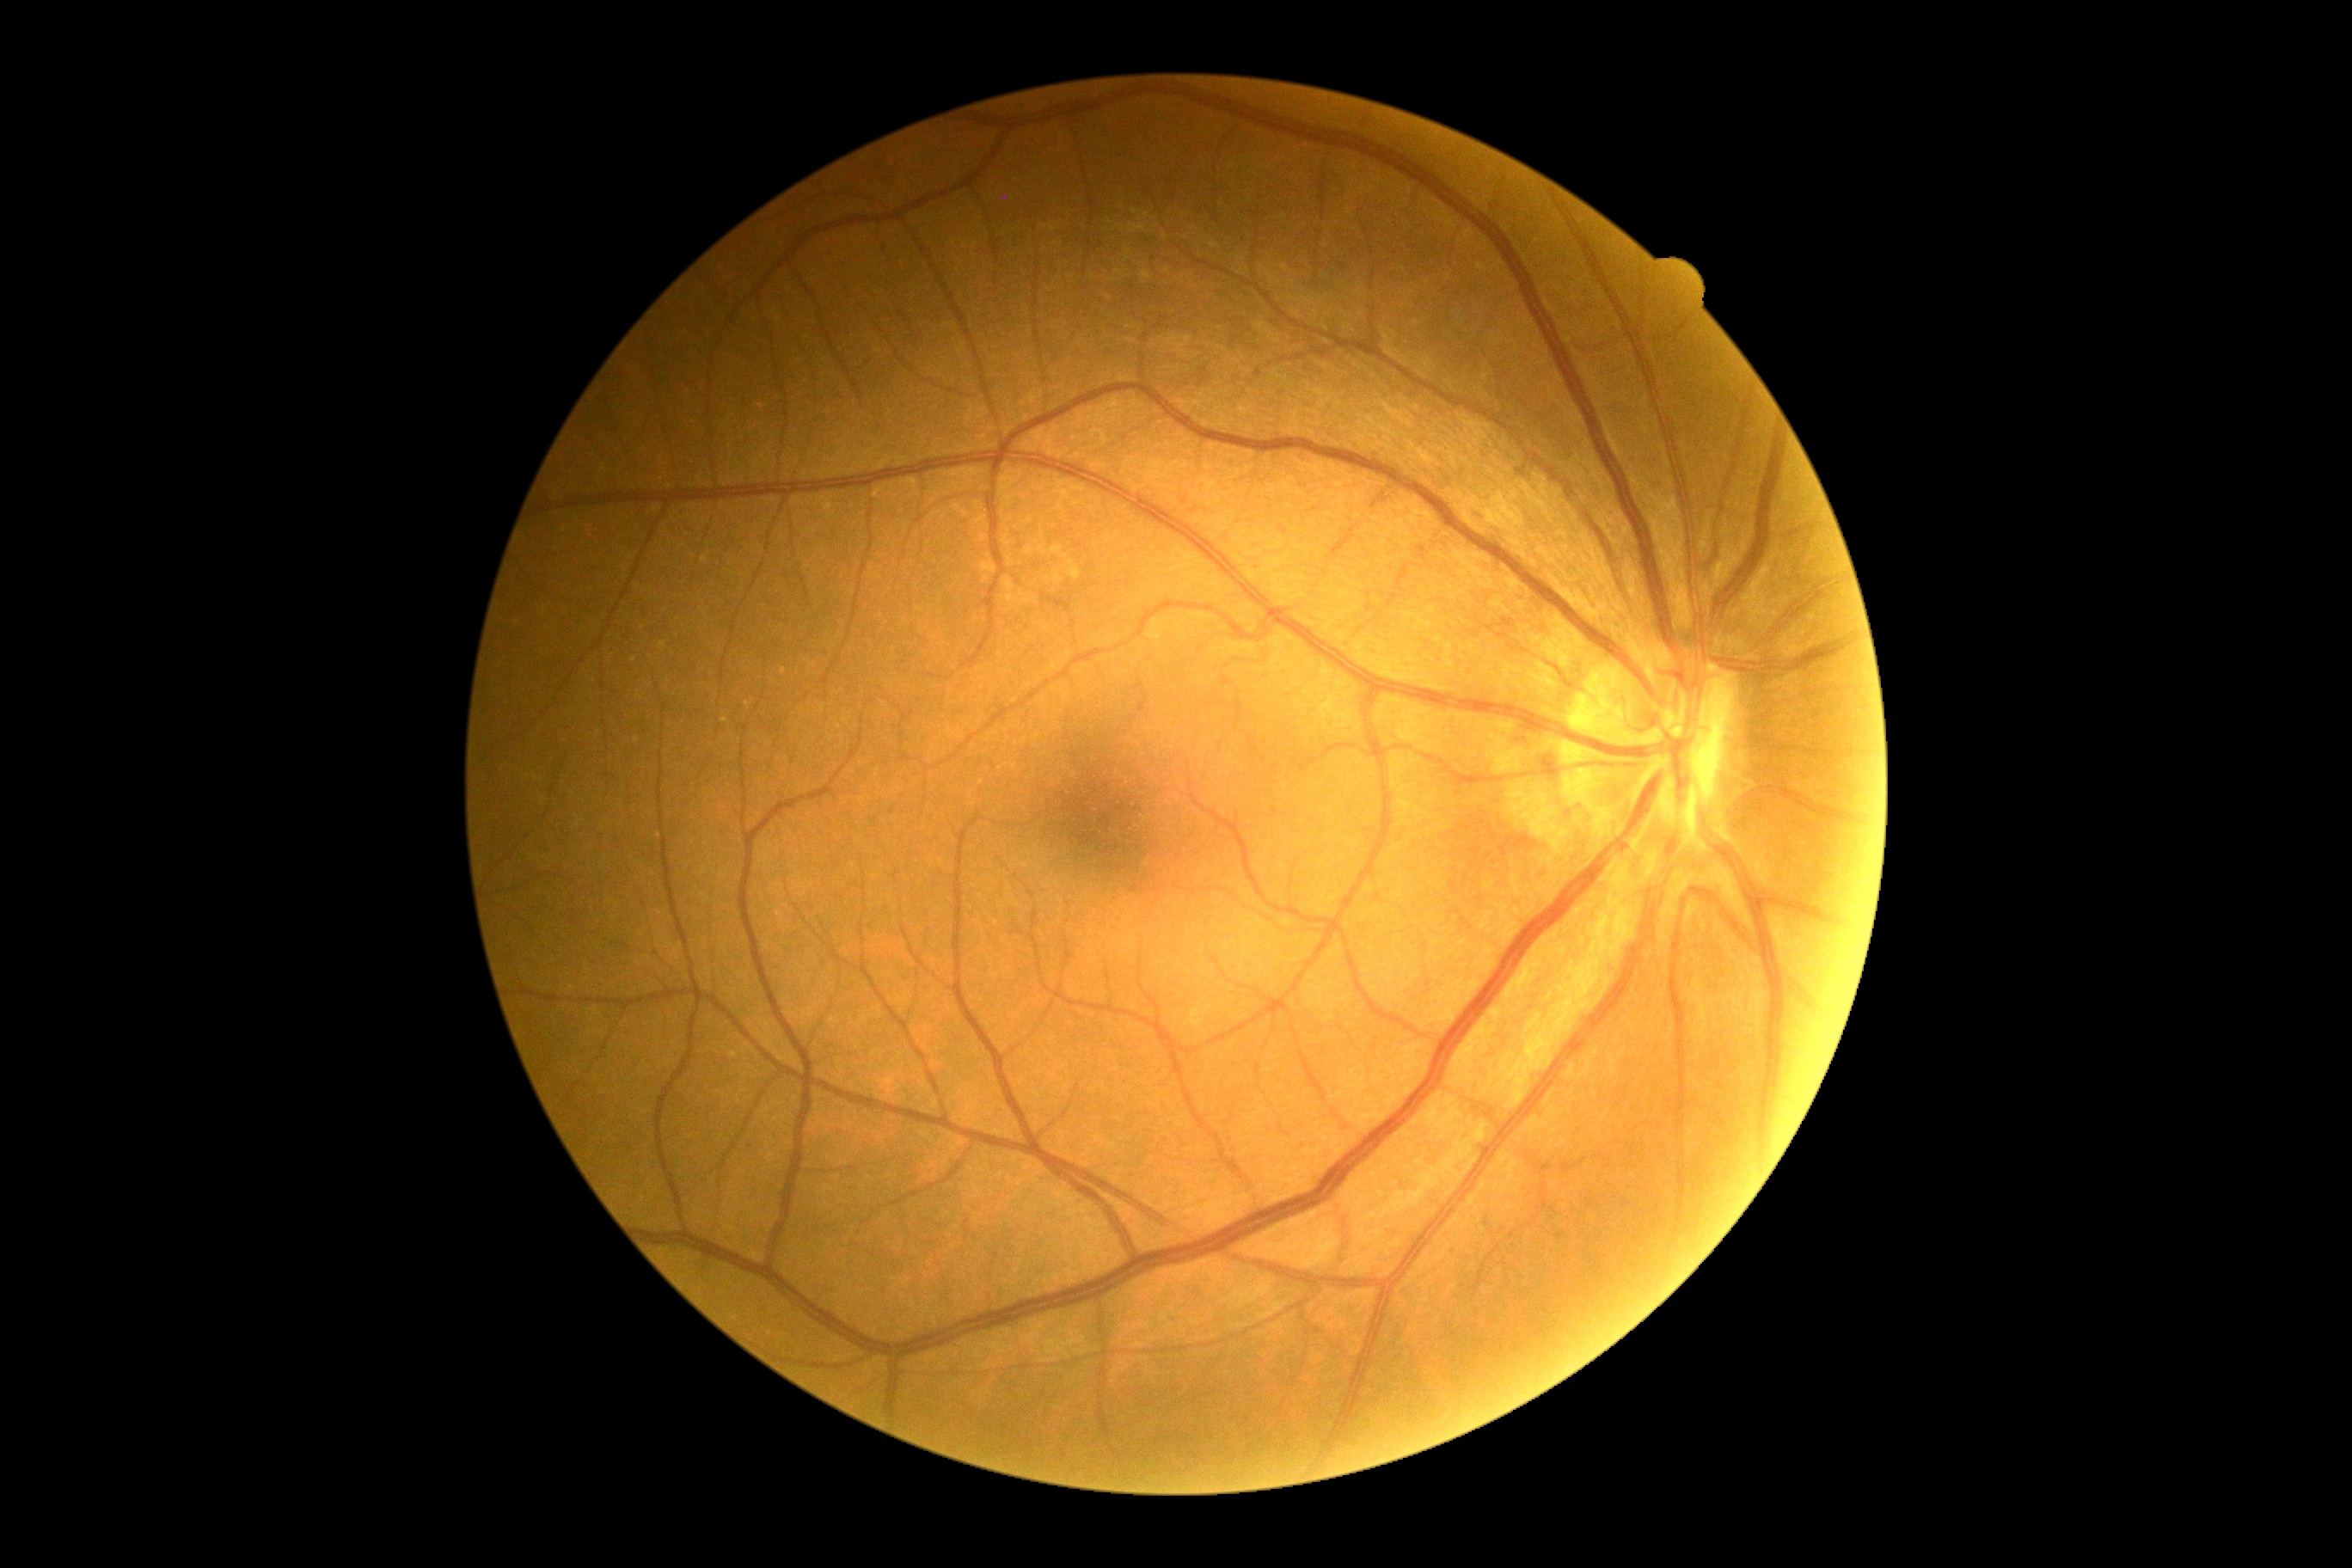 Diabetic retinopathy (DR): grade 0 (no apparent retinopathy) — no visible signs of diabetic retinopathy.
No diabetic retinal disease findings.